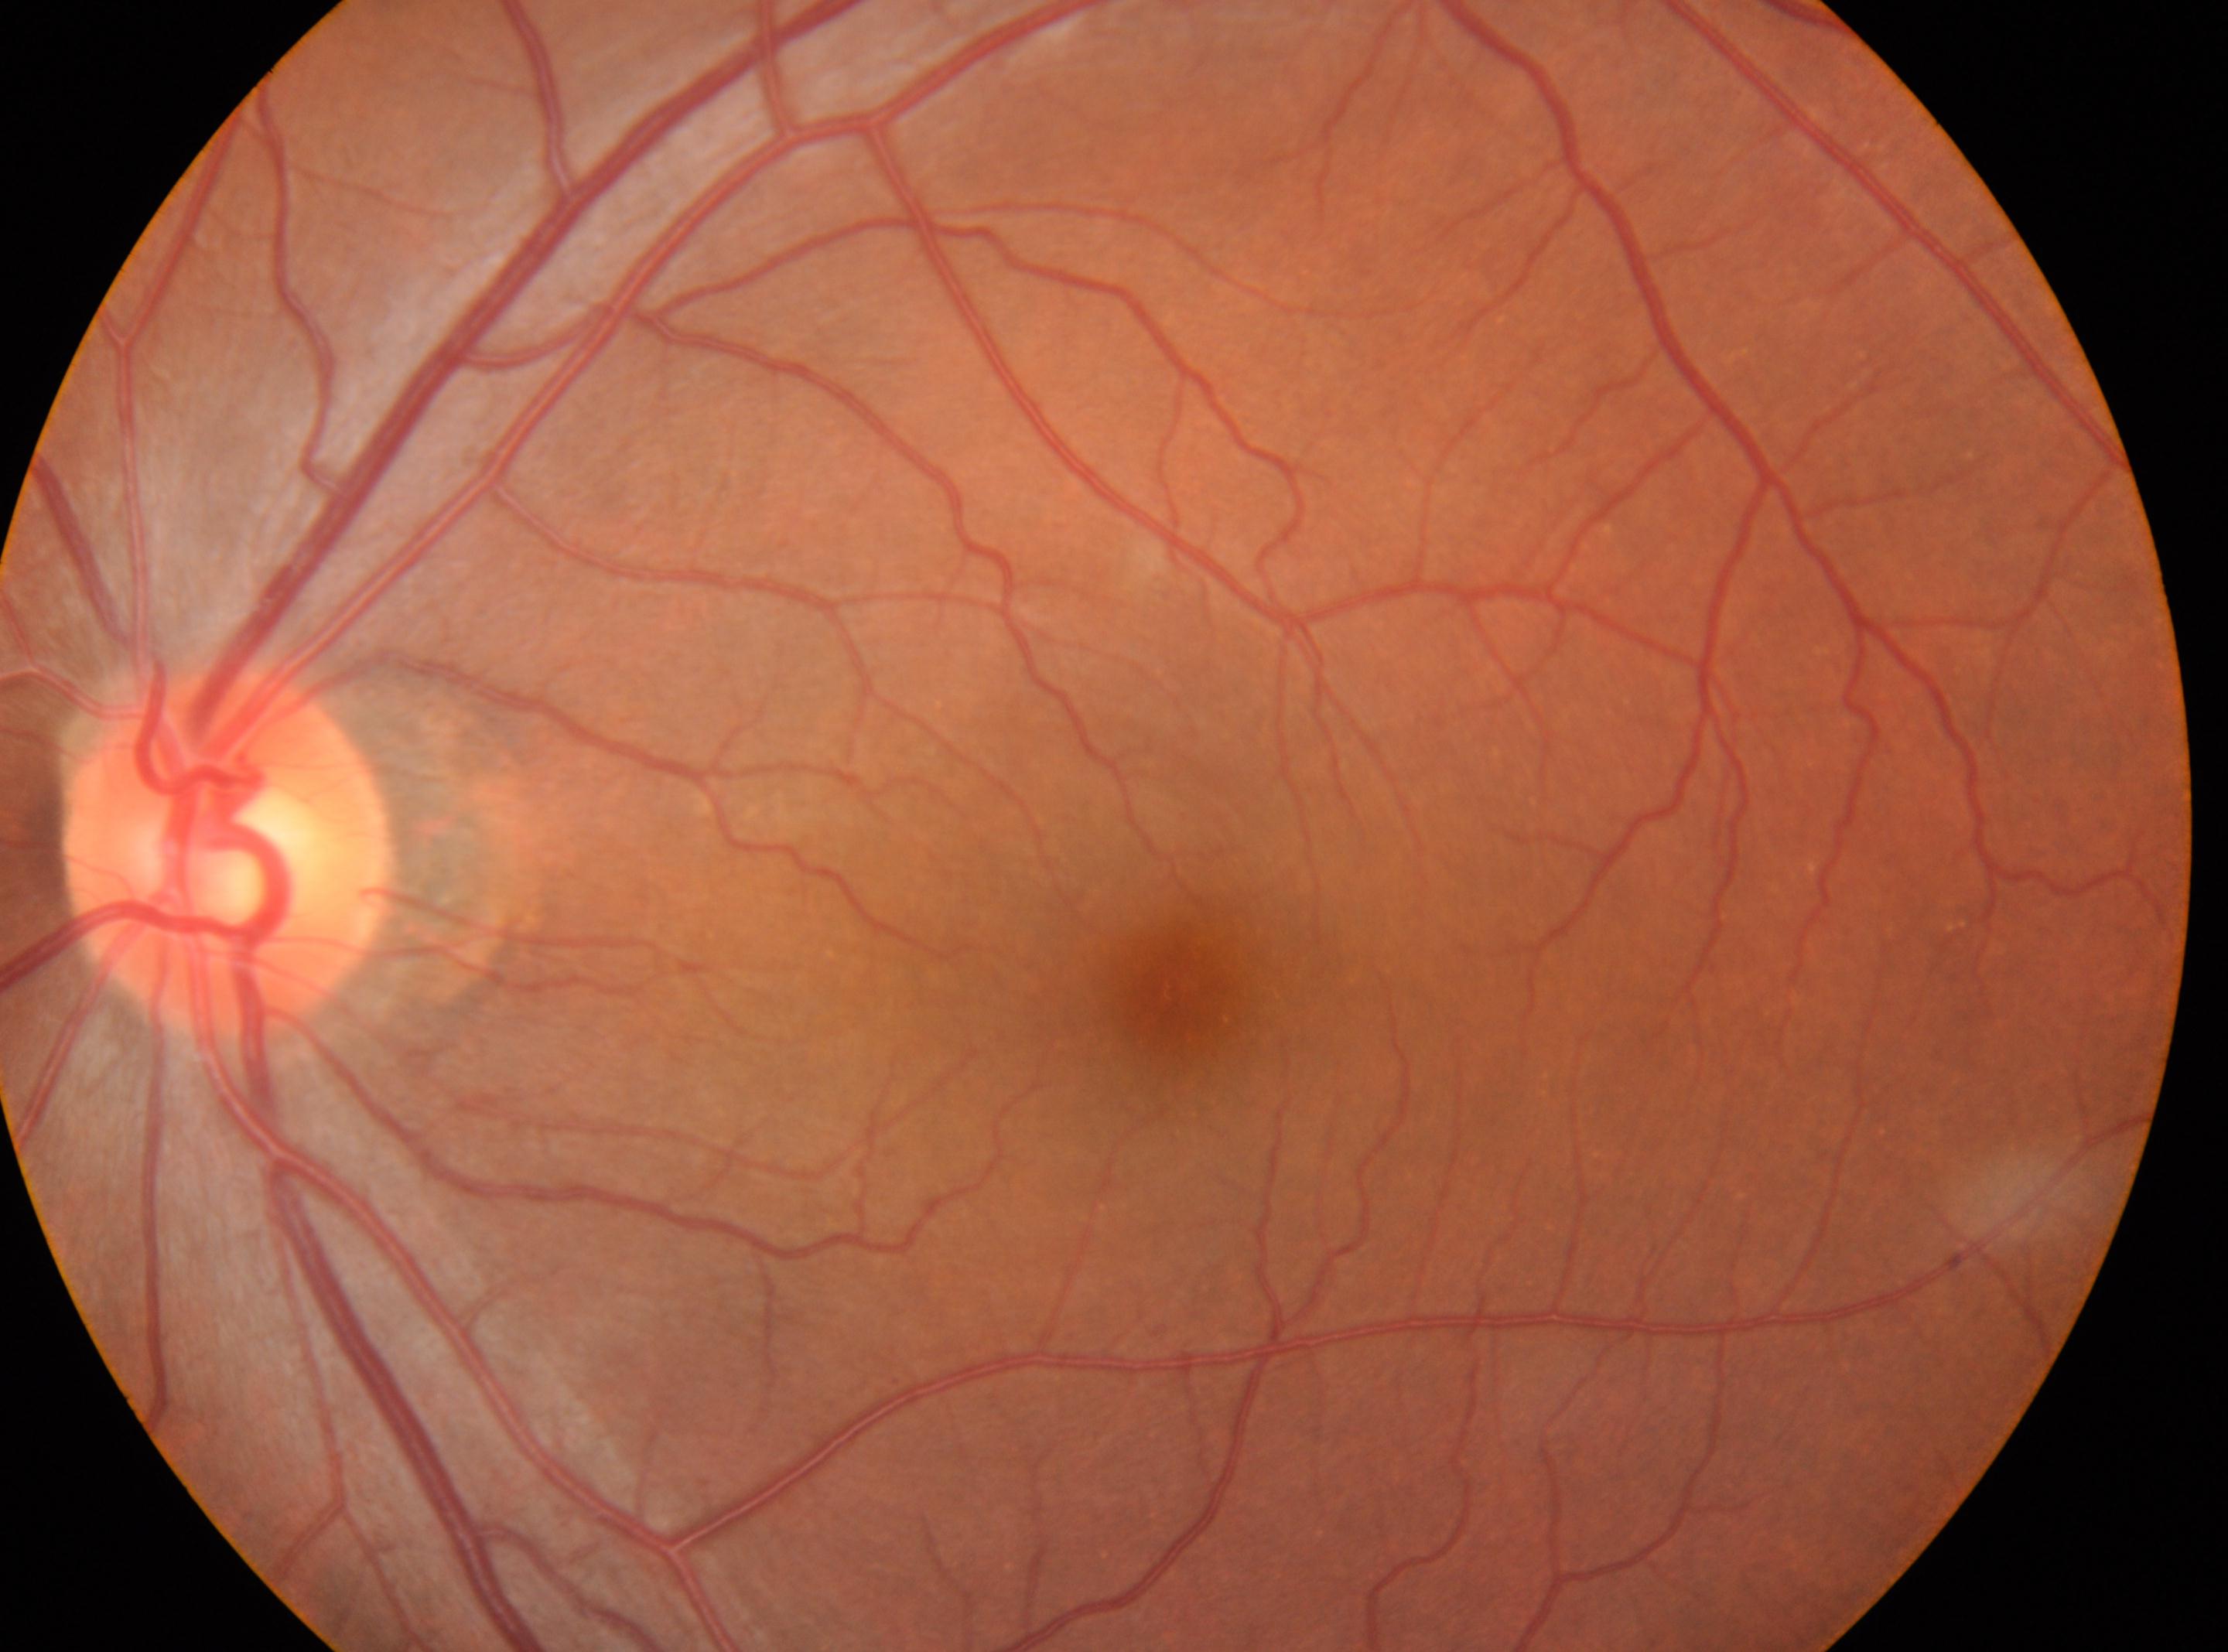 * diabetic retinopathy (DR): 0/4
* optic disc: 224px, 855px
* DR impression: No apparent diabetic retinopathy
* foveal center: 1181px, 987px
* laterality: left eye